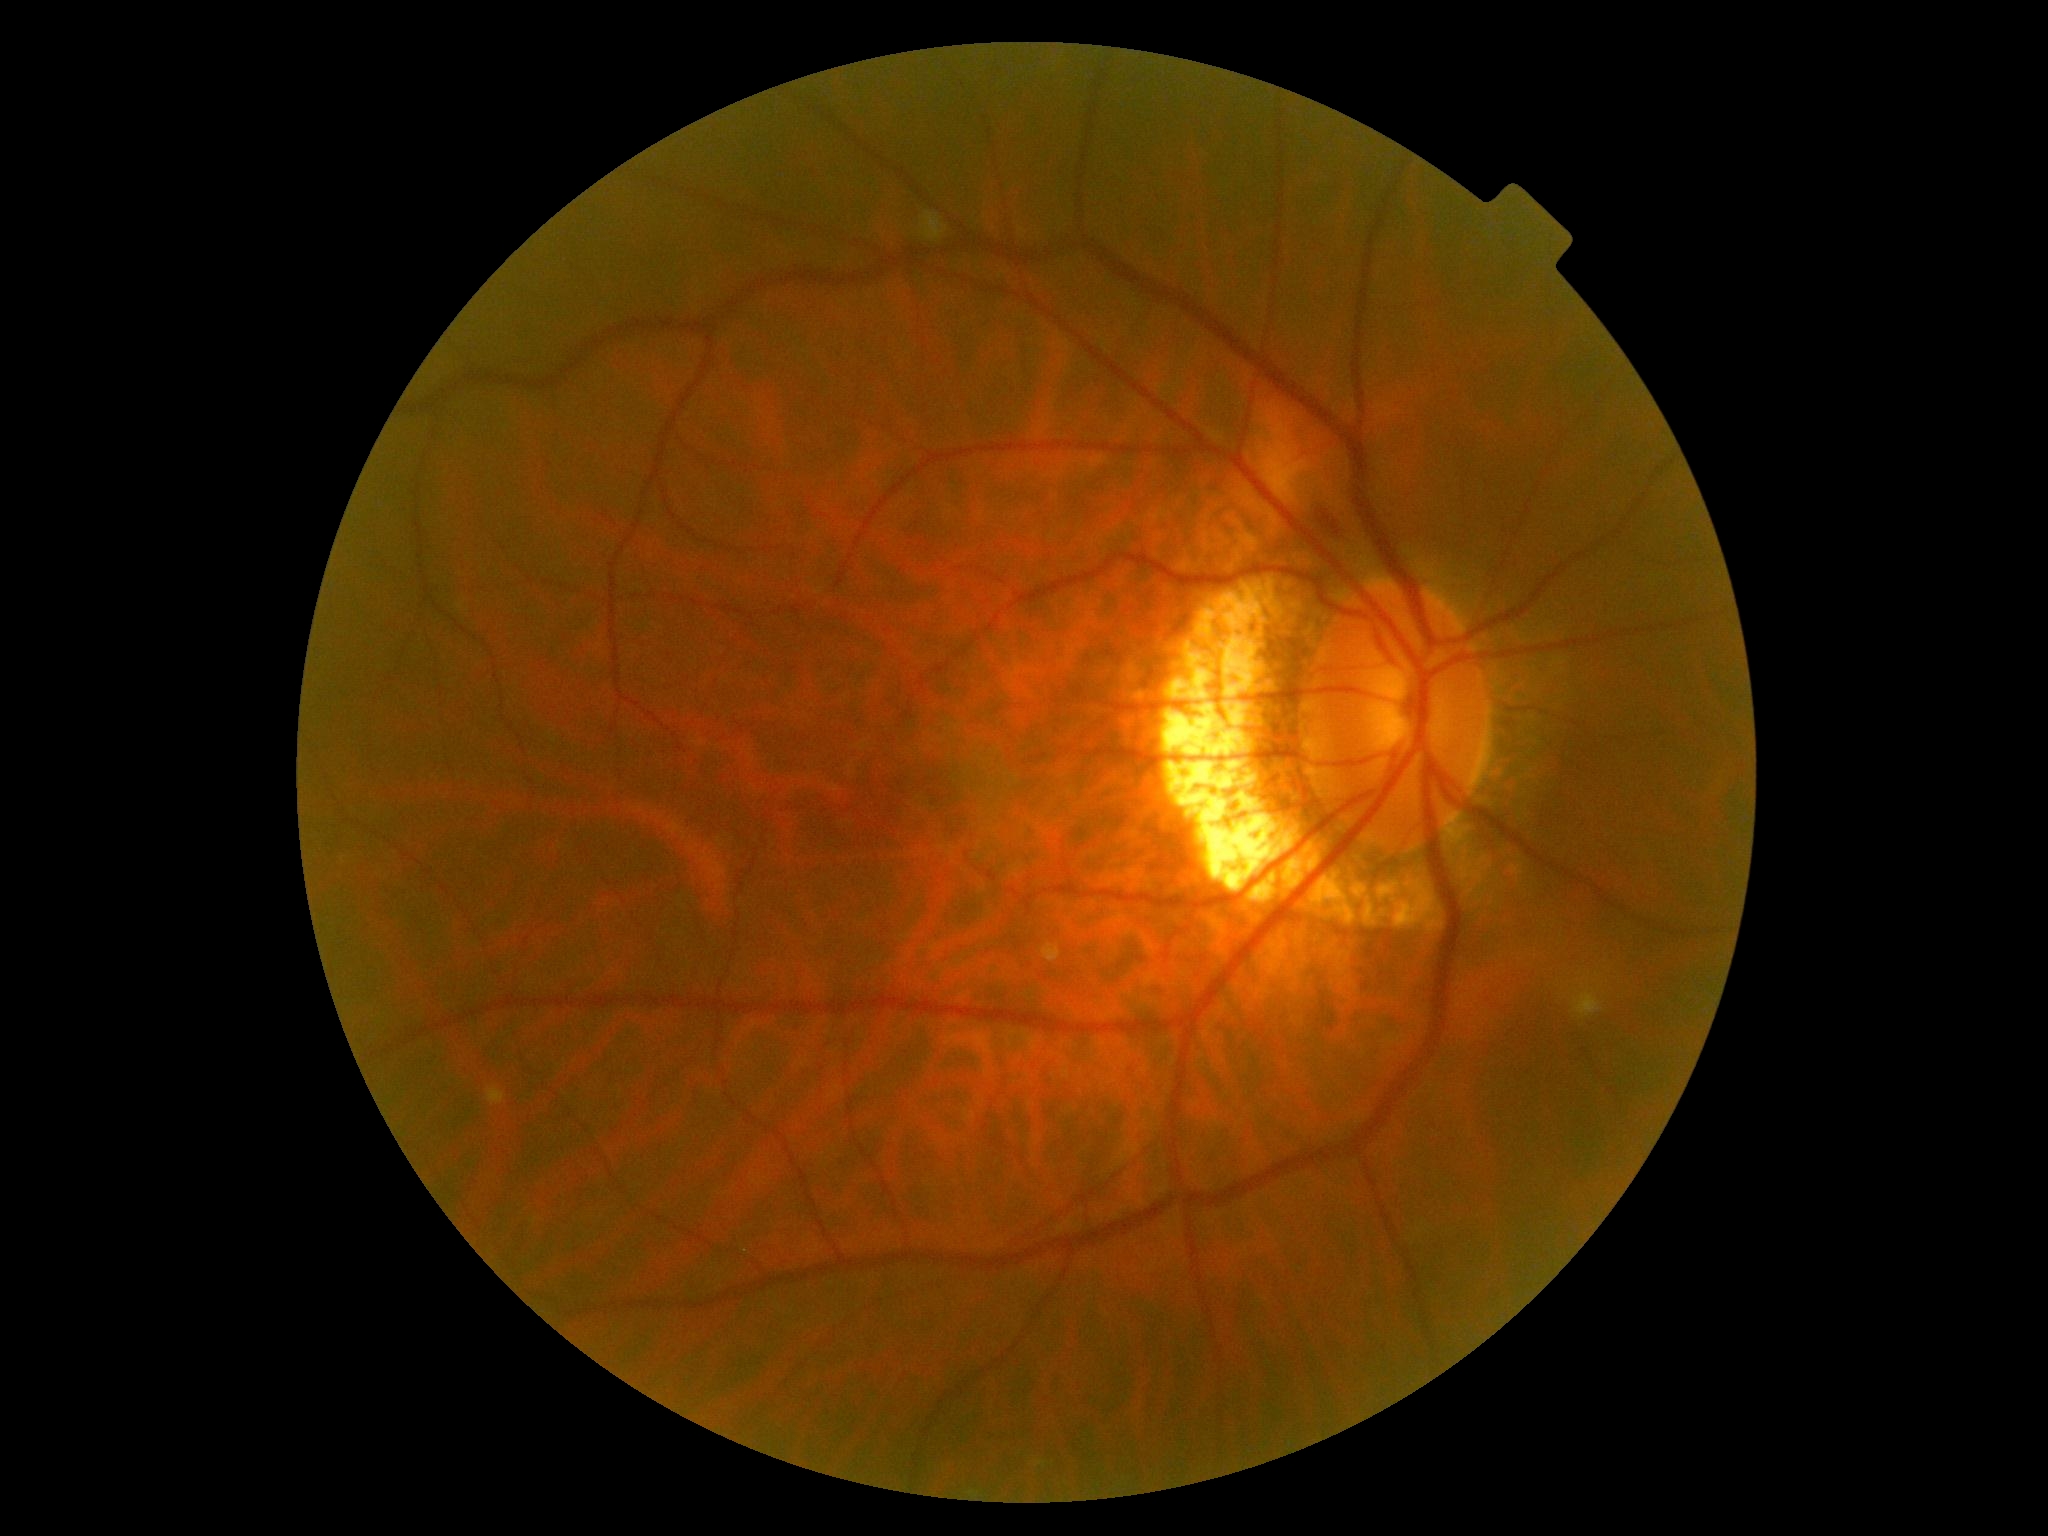

Diabetic retinopathy (DR): 2 — more than just microaneurysms but less than severe NPDR.